Image size 1932x1932 · FOV: 45 degrees.
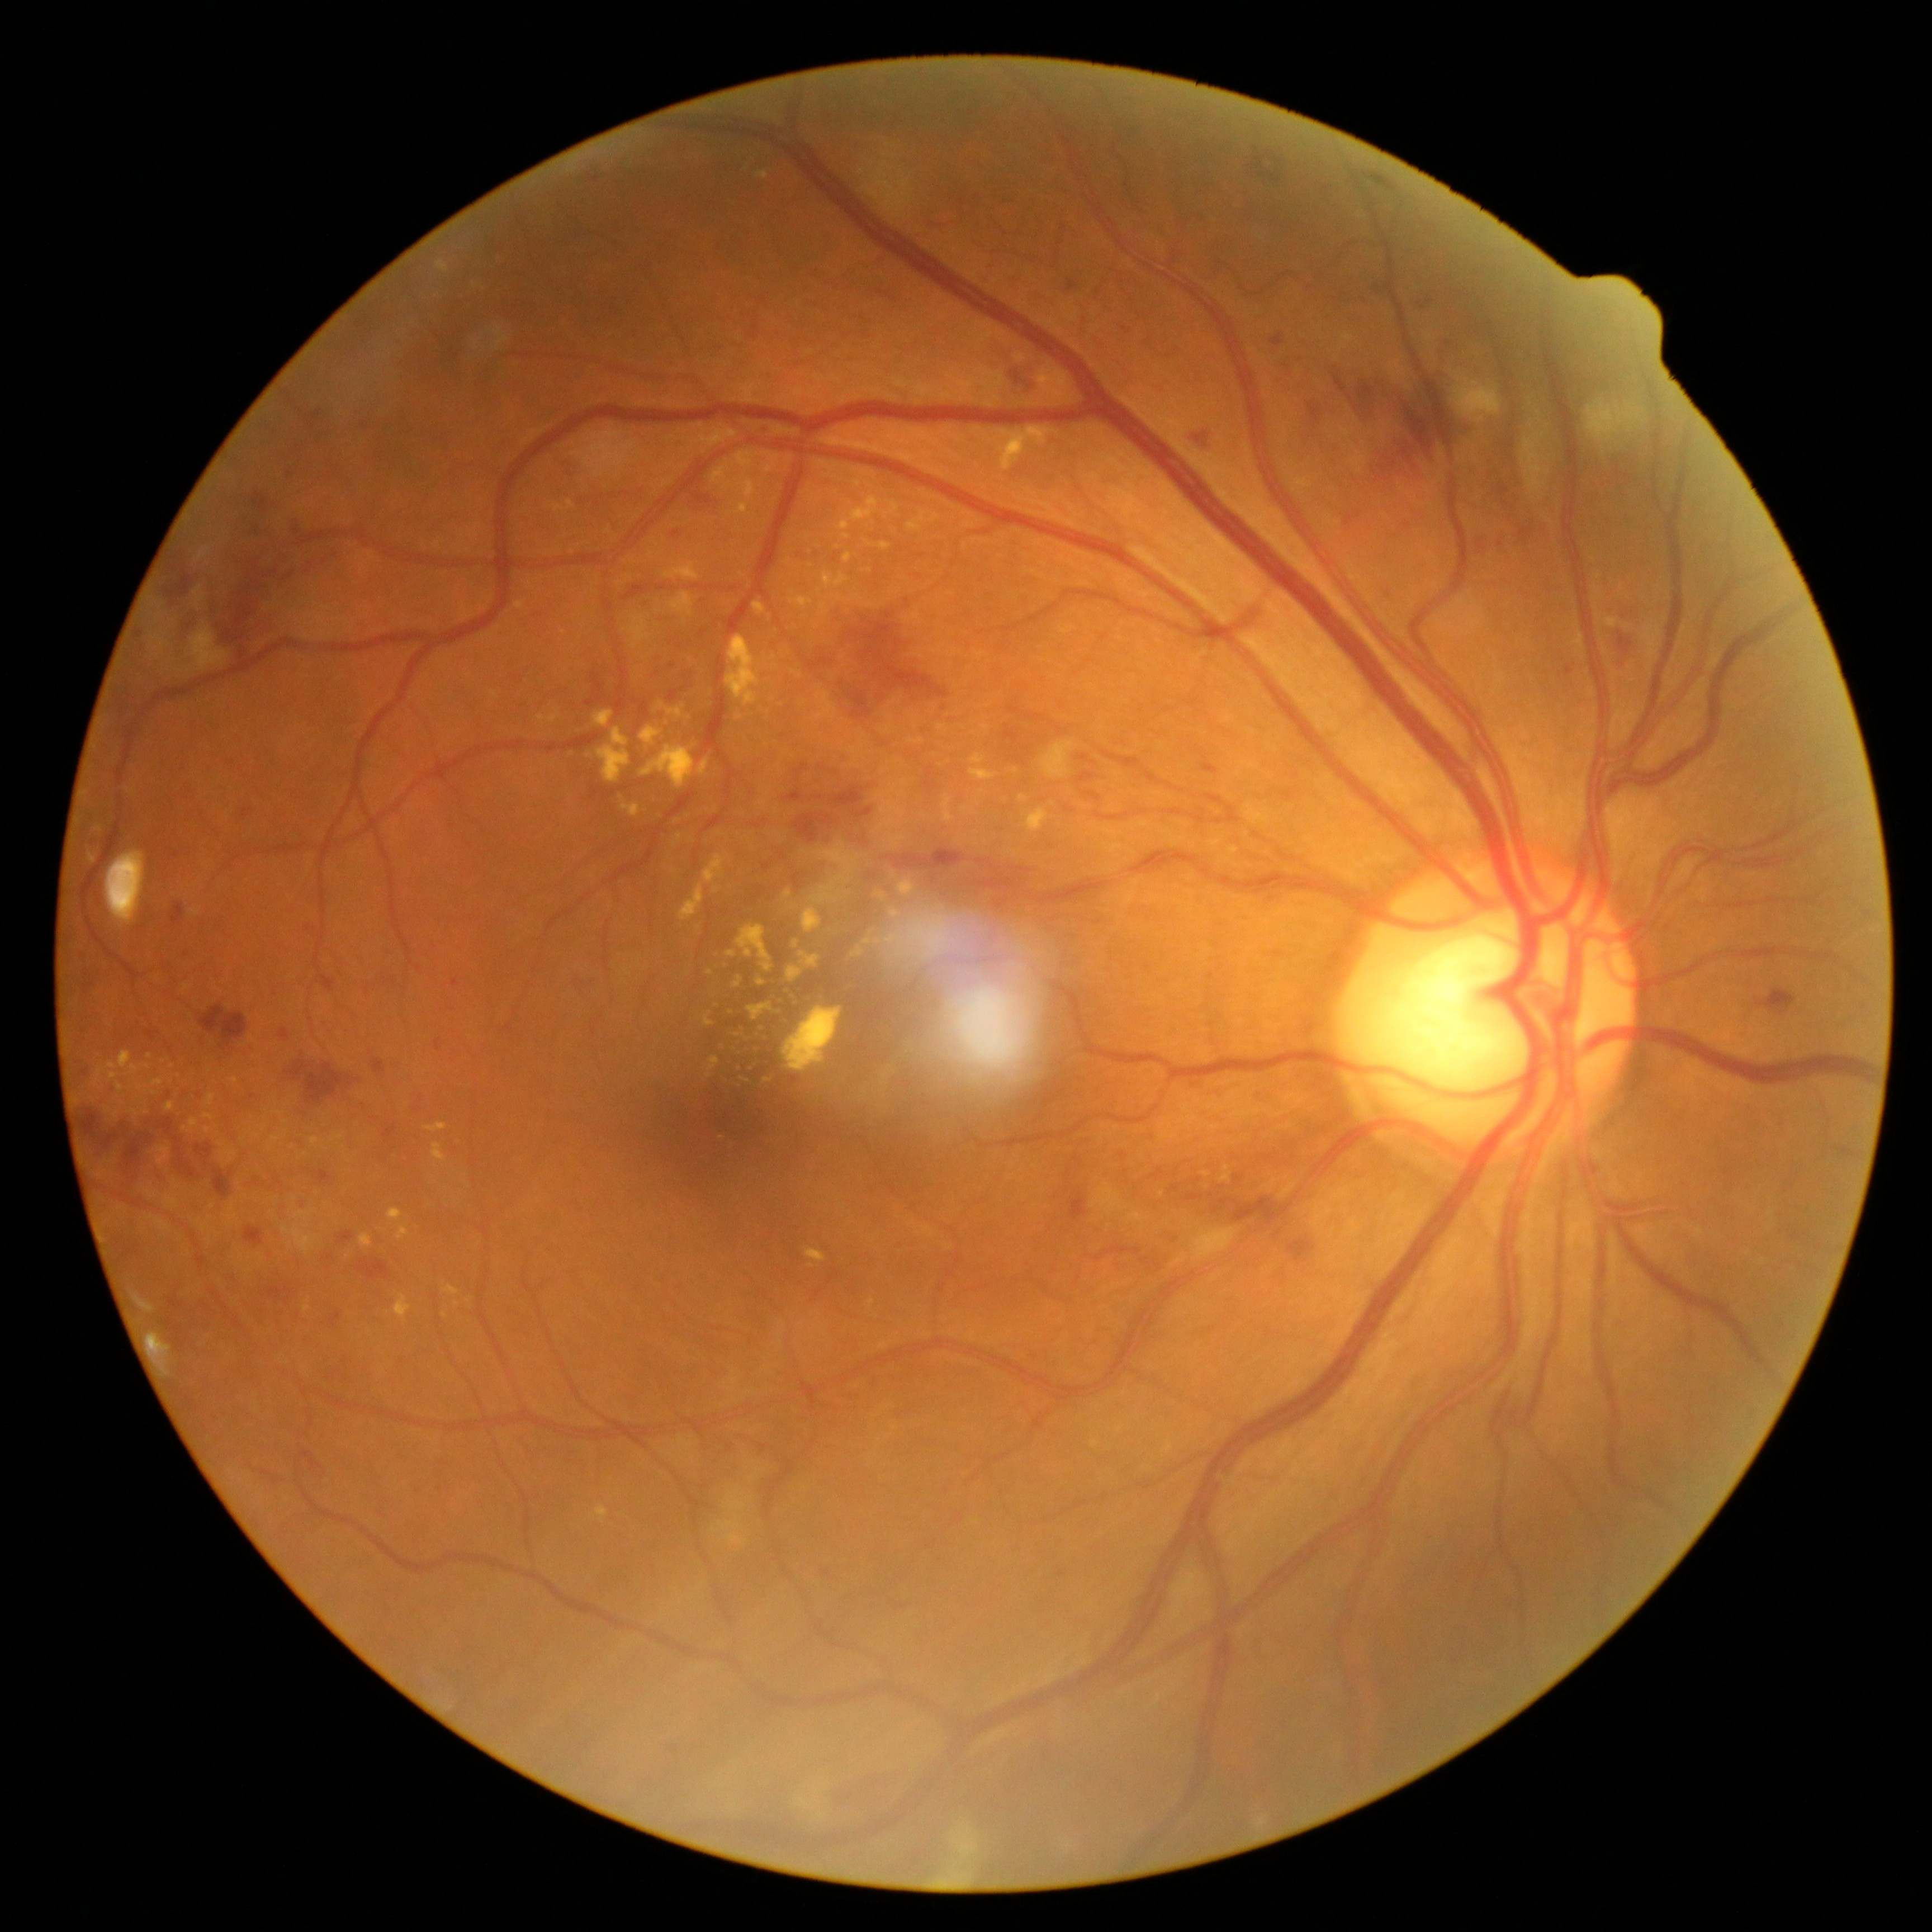 partial: true
dr_grade: 3
lesions:
  ex:
    - 204, 1113, 214, 1122
    - 305, 1304, 311, 1313
    - 137, 1077, 166, 1094
    - 791, 598, 813, 610
    - 784, 891, 793, 899
    - 595, 1505, 608, 1523
    - 828, 595, 844, 604
    - 282, 1227, 317, 1255
    - 971, 755, 986, 766
    - 680, 856, 727, 923
    - 704, 1015, 714, 1027
  ex_small:
    - 781/1001
    - 445/1316
    - 709/972
    - 154/1094
    - 676/821
    - 720/834
    - 270/1148